Image size 848x848; acquired with a NIDEK AFC-230; nonmydriatic; fundus photo; 45 degree fundus photograph:
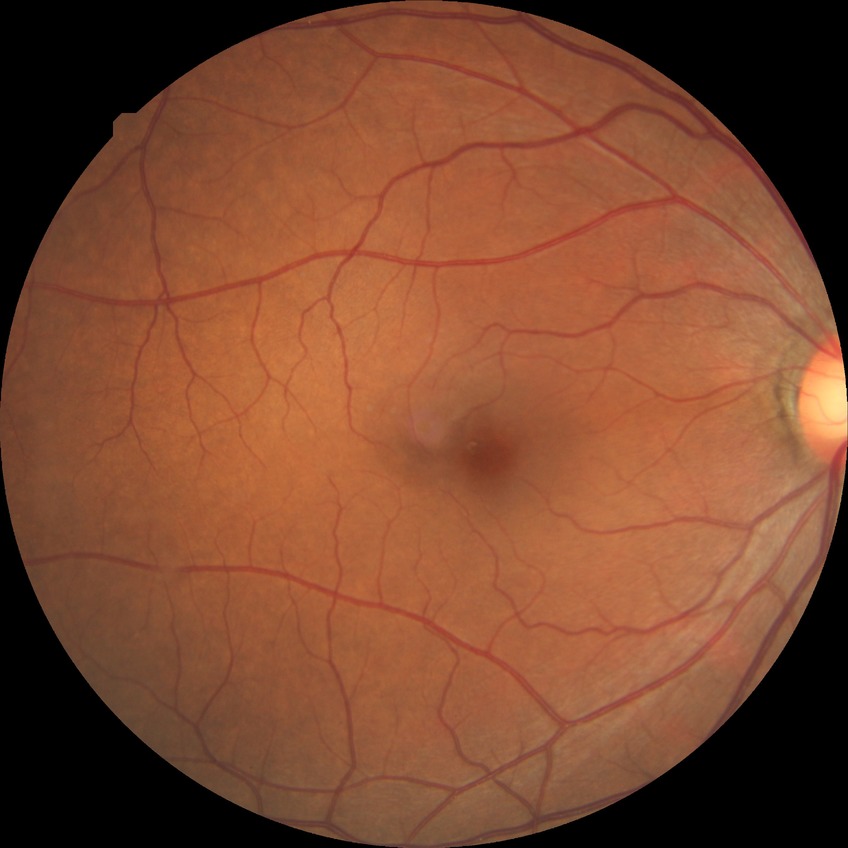 diabetic retinopathy grade=no diabetic retinopathy.